NIDEK AFC-230.
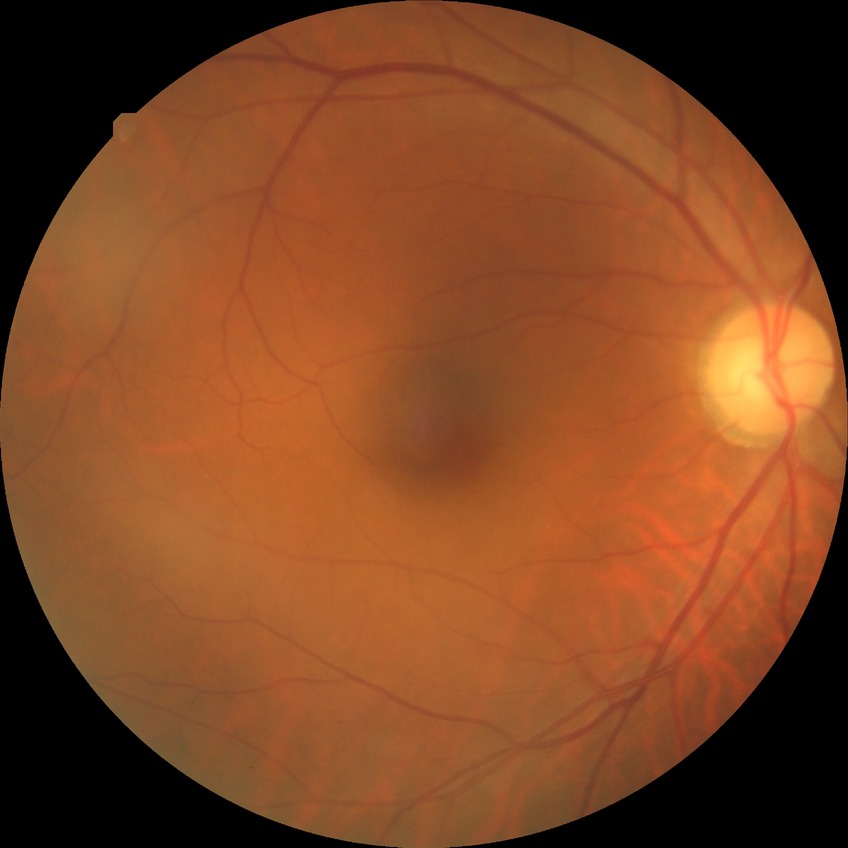

DR severity=NDR; DR impression=no DR findings.